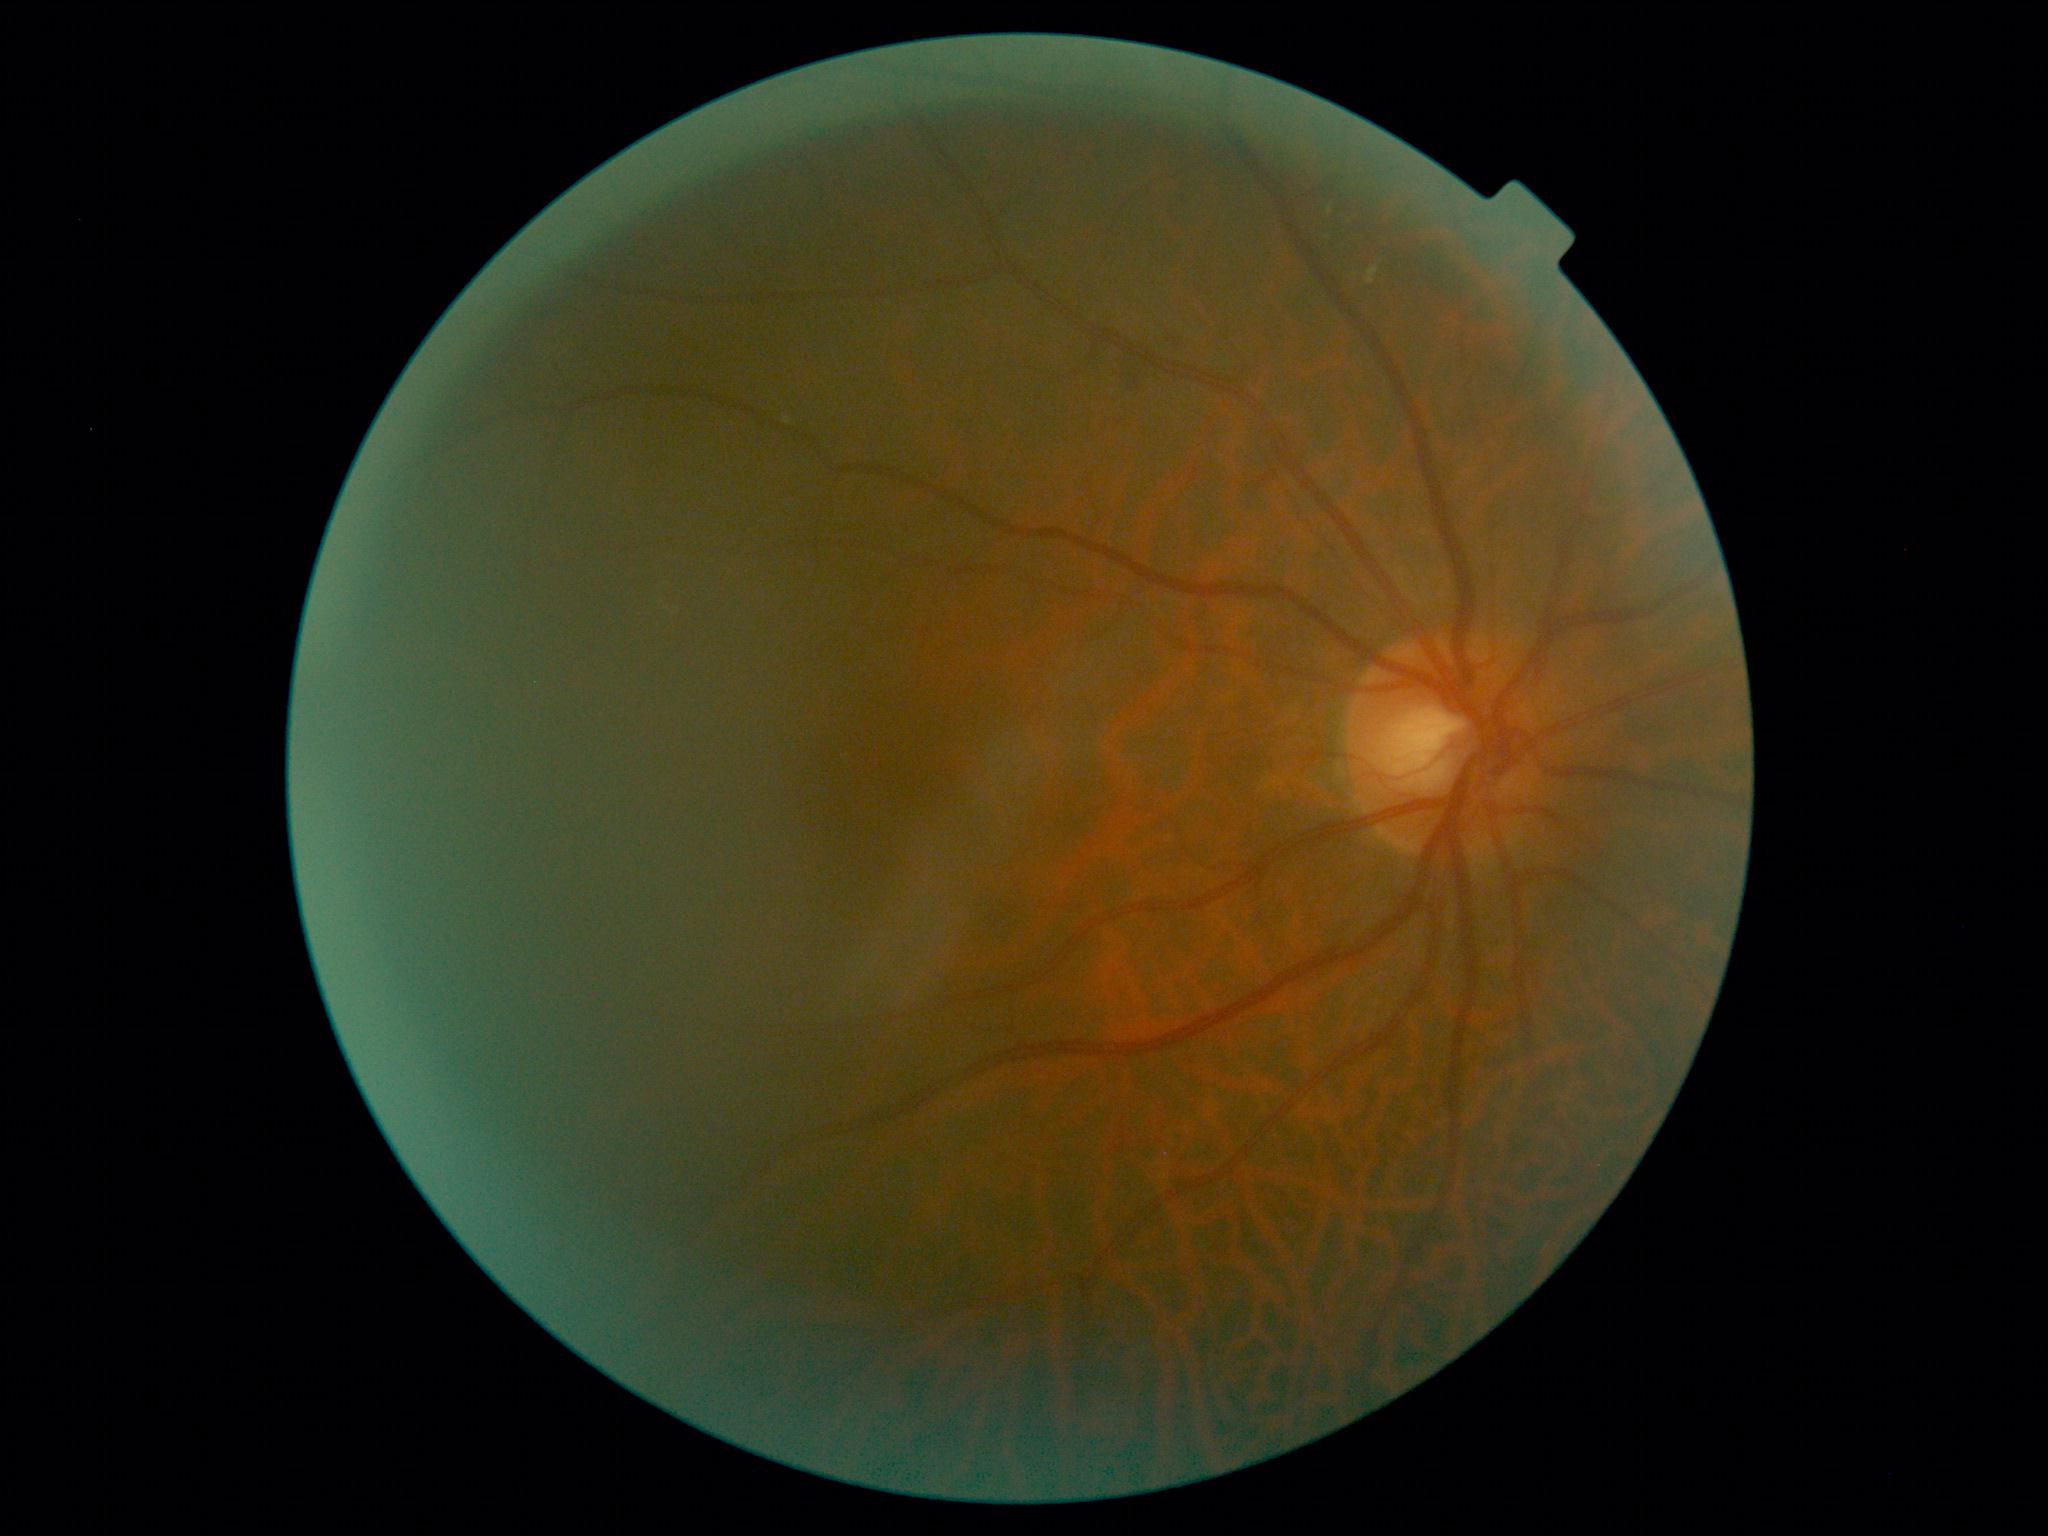
Diabetic retinopathy grade: 2.